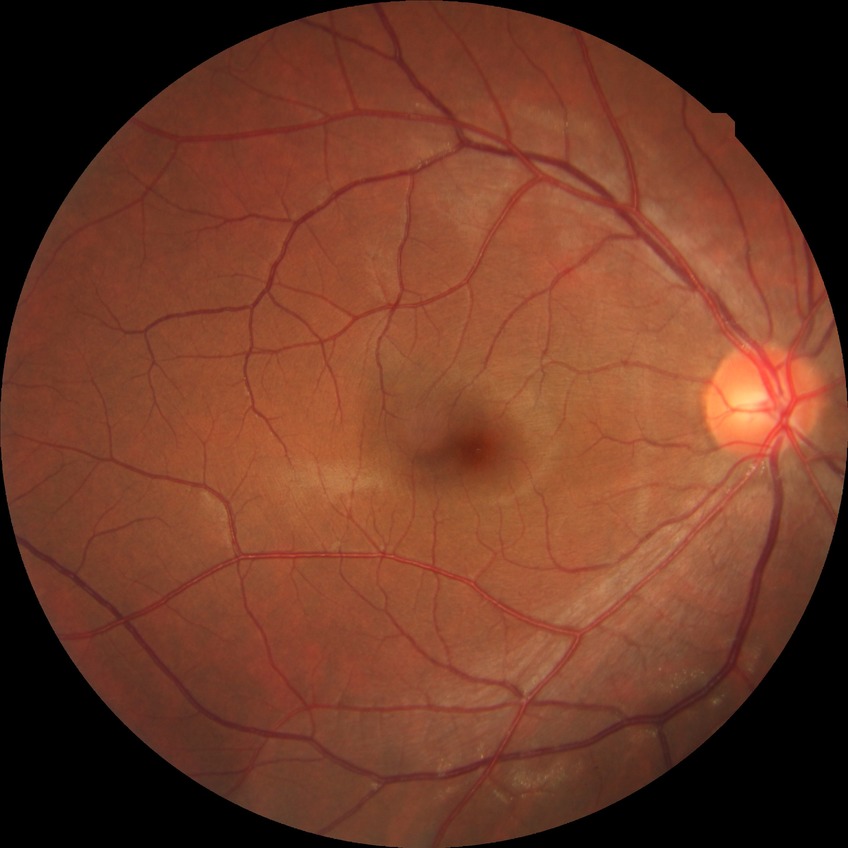
Modified Davis classification: no diabetic retinopathy.